2352 by 1568 pixels: 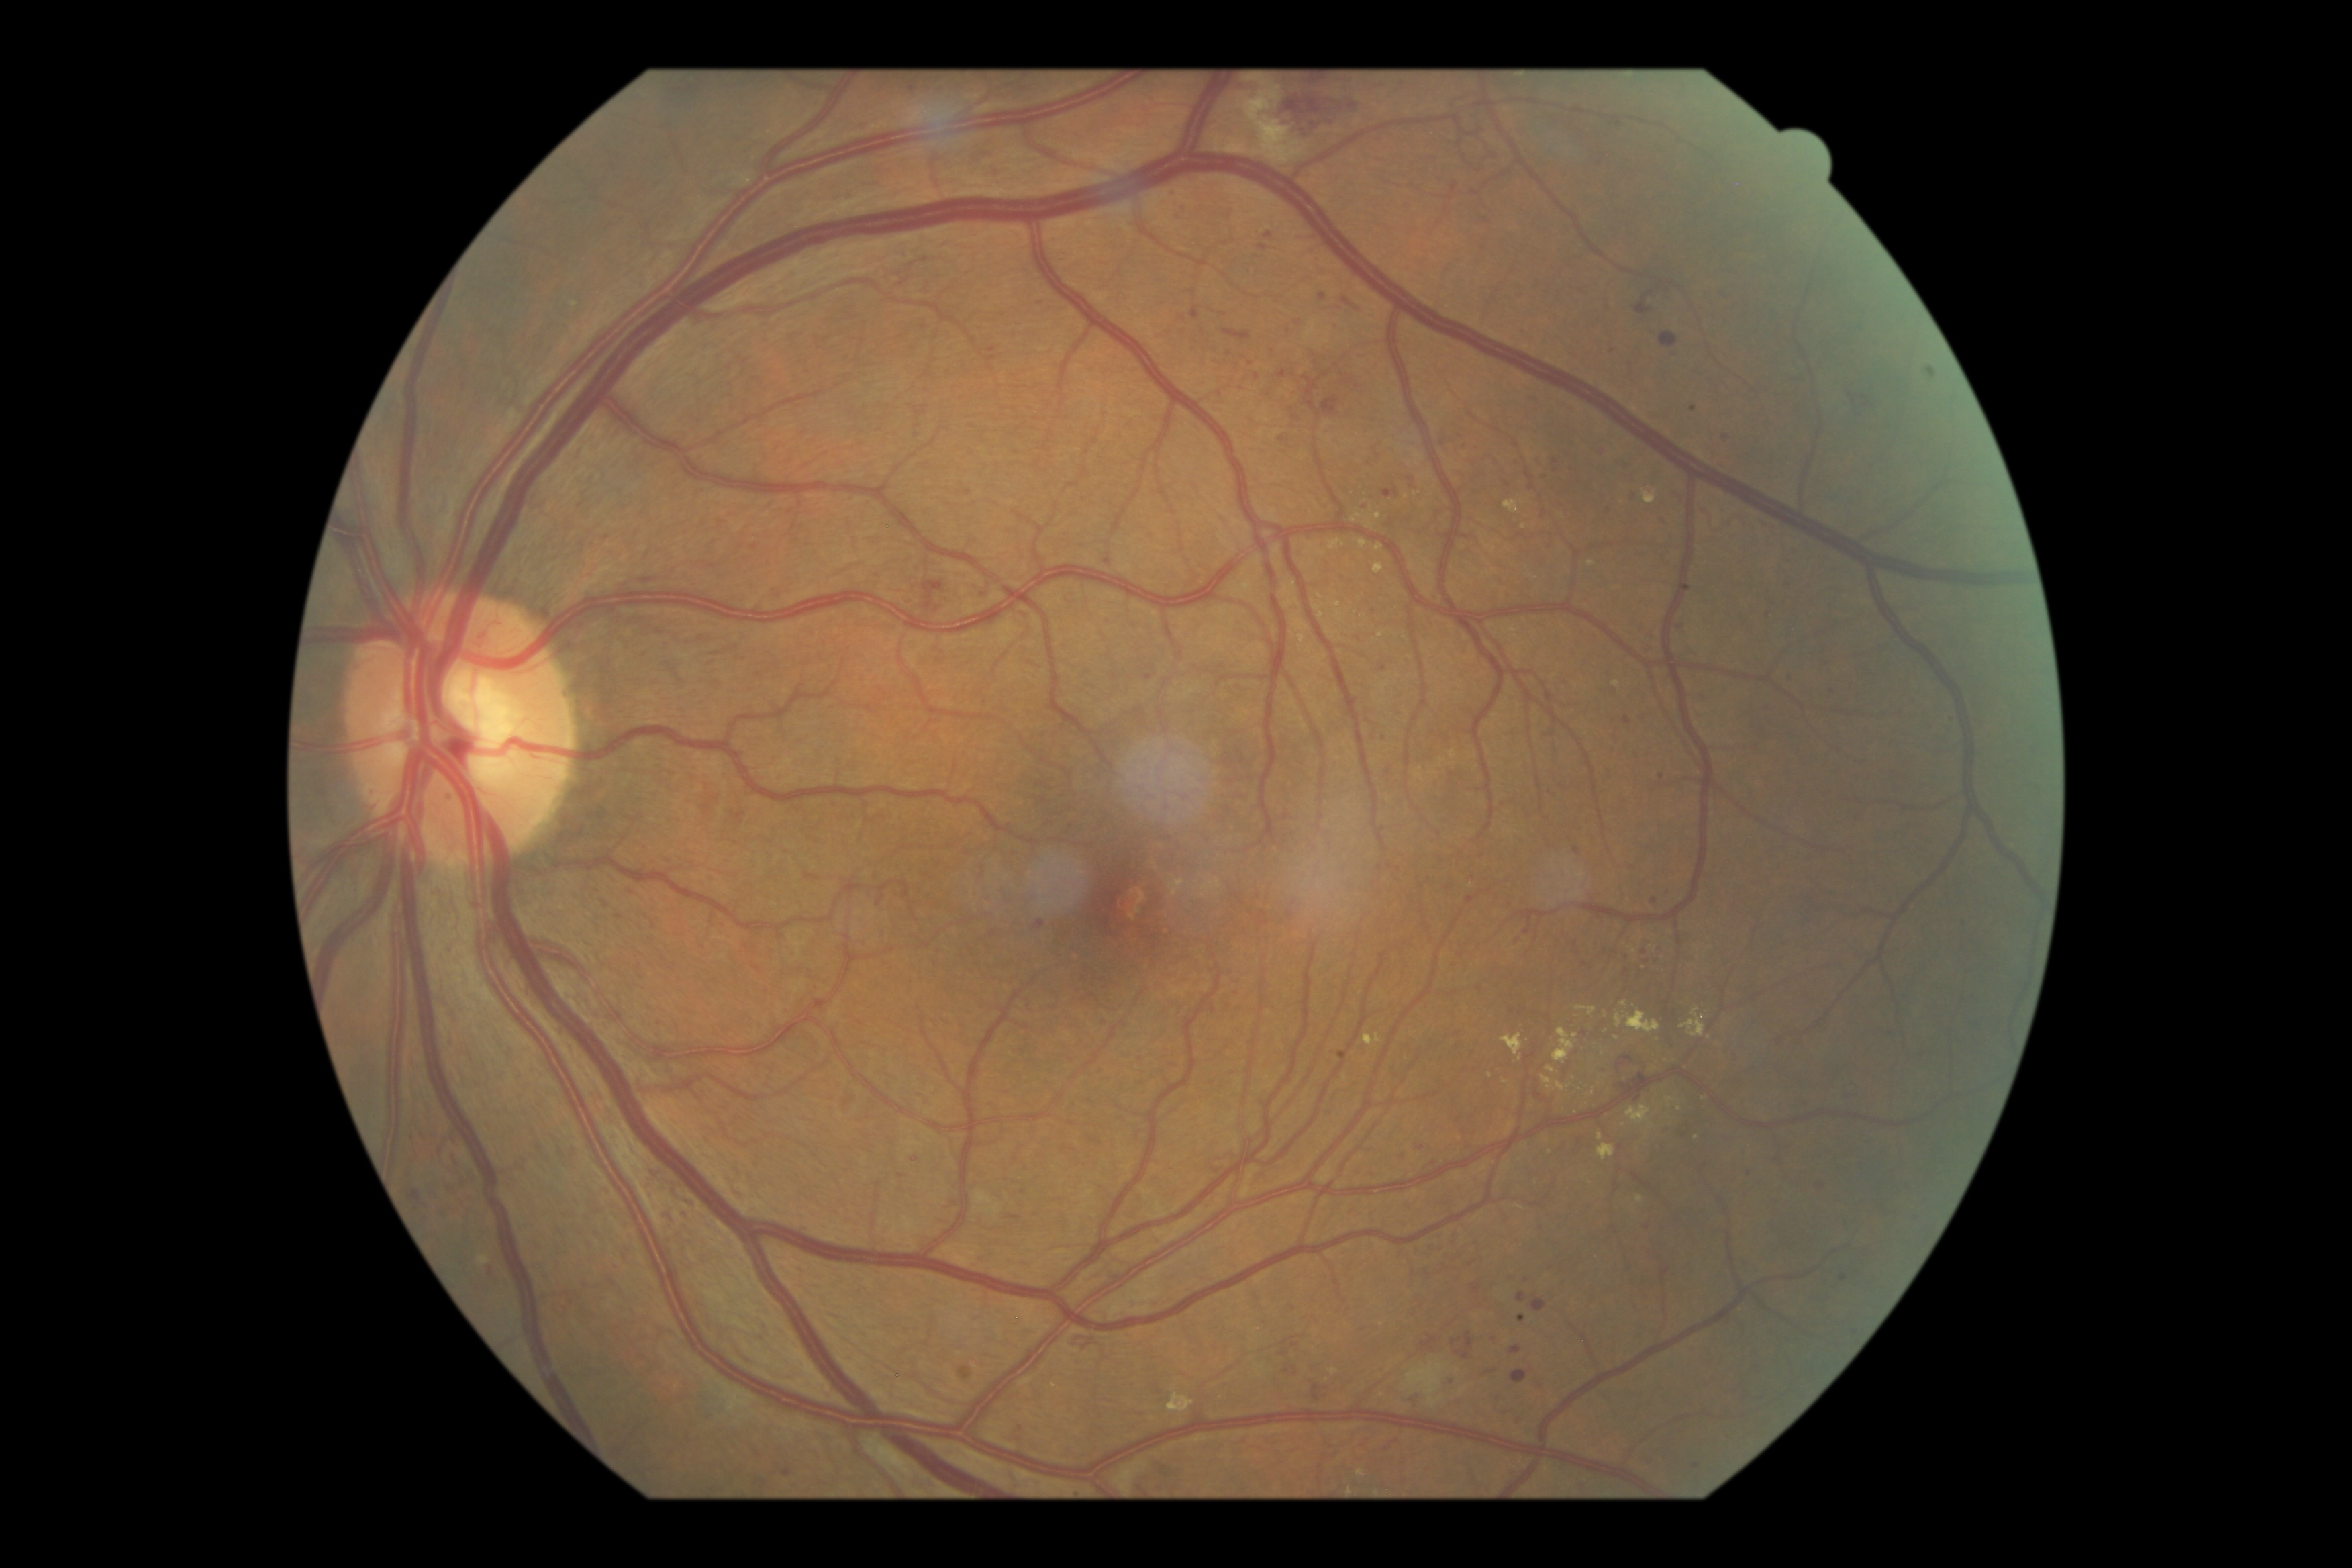 Retinopathy: 3/4
Lesions identified (partial list):
hemorrhages (partial) = [1222,328,1252,340], [1268,93,1358,139], [410,1191,422,1202], [1386,1434,1401,1449], [1342,299,1363,313], [452,1154,458,1171], [444,1204,449,1221], [735,813,744,822], [1409,1391,1422,1405], [1617,1056,1634,1071], [1636,297,1652,316], [1511,1371,1528,1385]
microaneurysms (partial) = [1382,487,1394,499], [1492,1338,1499,1346], [1369,606,1374,616], [1660,519,1665,527], [1260,245,1268,250], [1468,896,1476,905], [1265,234,1273,238], [1655,958,1663,966], [1724,434,1731,444], [1596,450,1605,453]
Additional small microaneurysms near x=1183 y=219, x=1626 y=974, x=1172 y=194, x=1487 y=222, x=1462 y=446, x=1527 y=932, x=1223 y=314, x=1747 y=1265, x=1380 y=868
hard exudates (partial) = [1335,611,1344,624], [1375,544,1383,552], [1628,1106,1655,1131], [1598,1144,1616,1161], [1359,540,1369,550], [1170,1402,1177,1410], [1616,1012,1660,1034], [1363,1036,1382,1046], [1598,1132,1604,1142], [1557,1083,1570,1093]
Additional small hard exudates near x=1625 y=1005, x=1697 y=1139, x=1526 y=1148, x=1520 y=1207, x=1378 y=517
soft exudates = [1244,80,1287,144]